640x480 · wide-field fundus photograph from neonatal ROP screening · 130° field of view (Clarity RetCam 3):
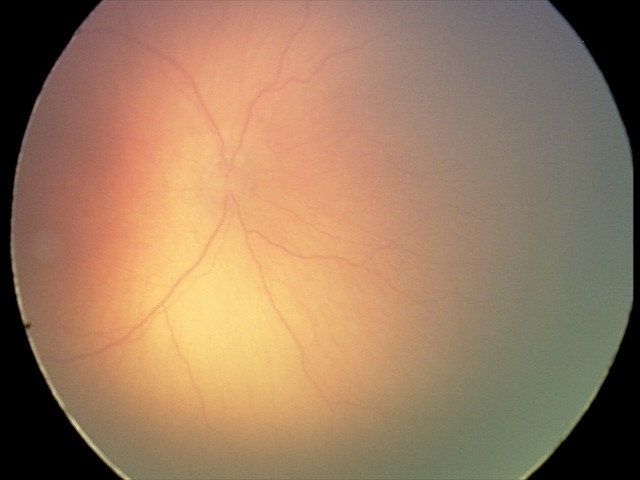 Diagnosis: ROP stage 1 | plus form: absent.